Color fundus photograph.
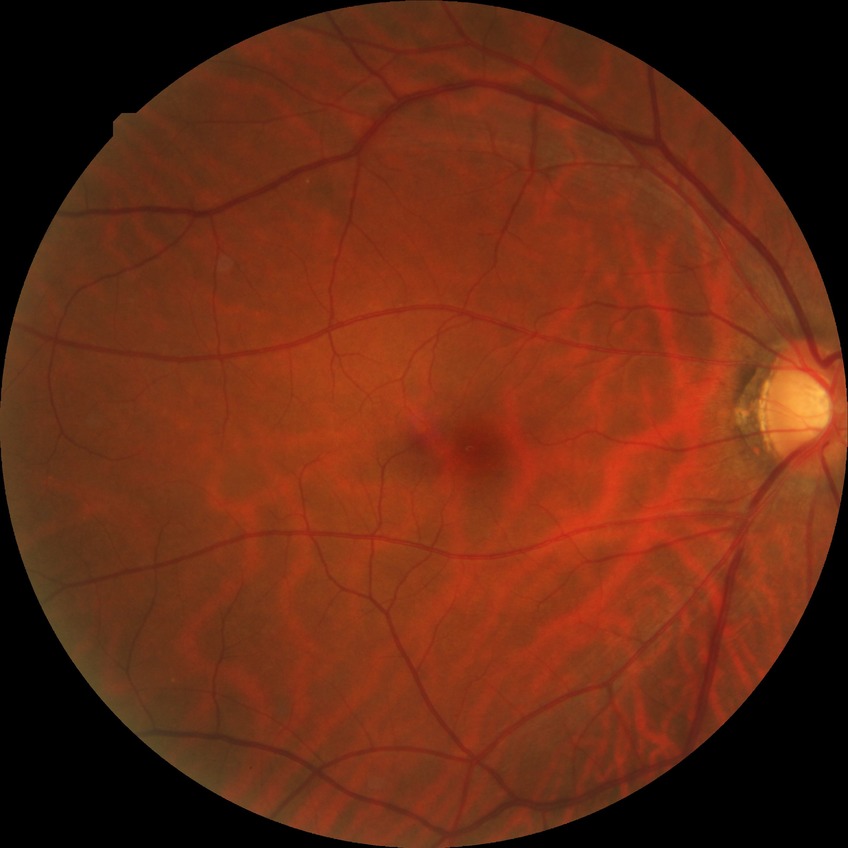 {"davis_grade": "no diabetic retinopathy (NDR)"}